30-degree field of view. Visual field mean deviation: 0.17 dB. Intraocular pressure by non-contact tonometry: 18 mmHg. Sex: F. Undilated pupil. 2212x1661. Corneal thickness 558 µm. Acquired with a Topcon TRC-NW400. CFP.
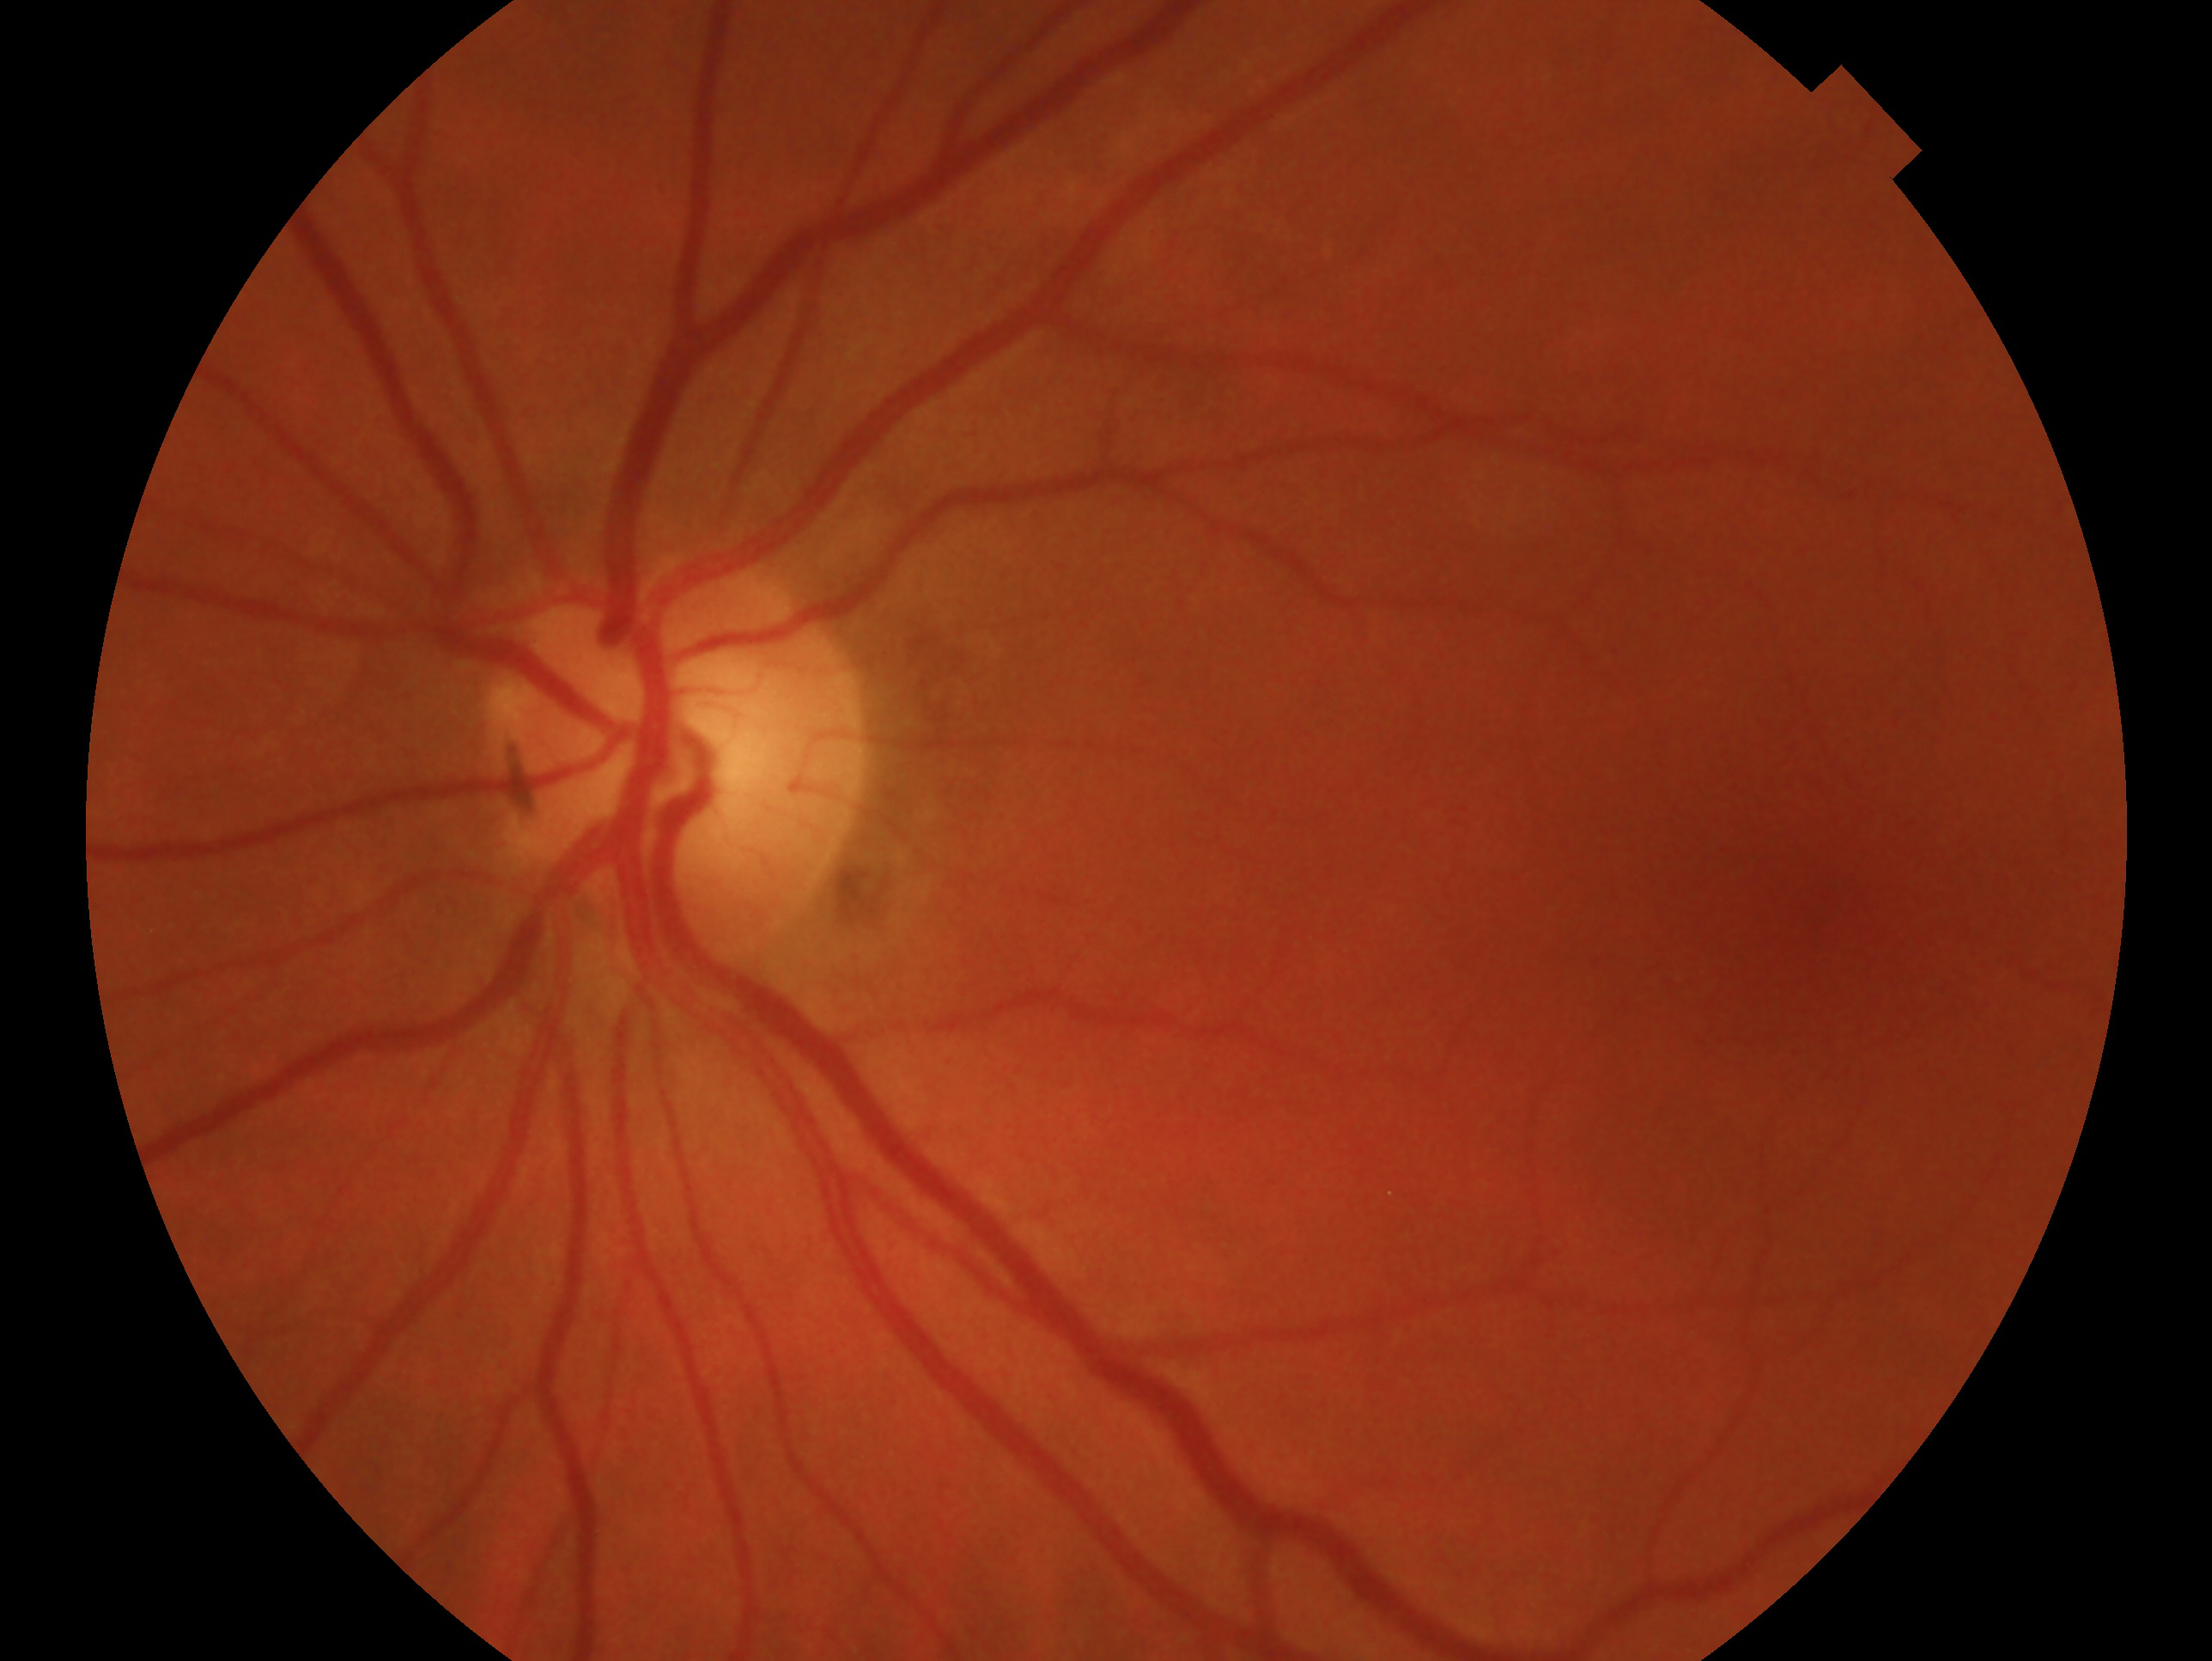

Glaucoma assessment — glaucomatous. Imaged eye: OS.